FOV: 45 degrees:
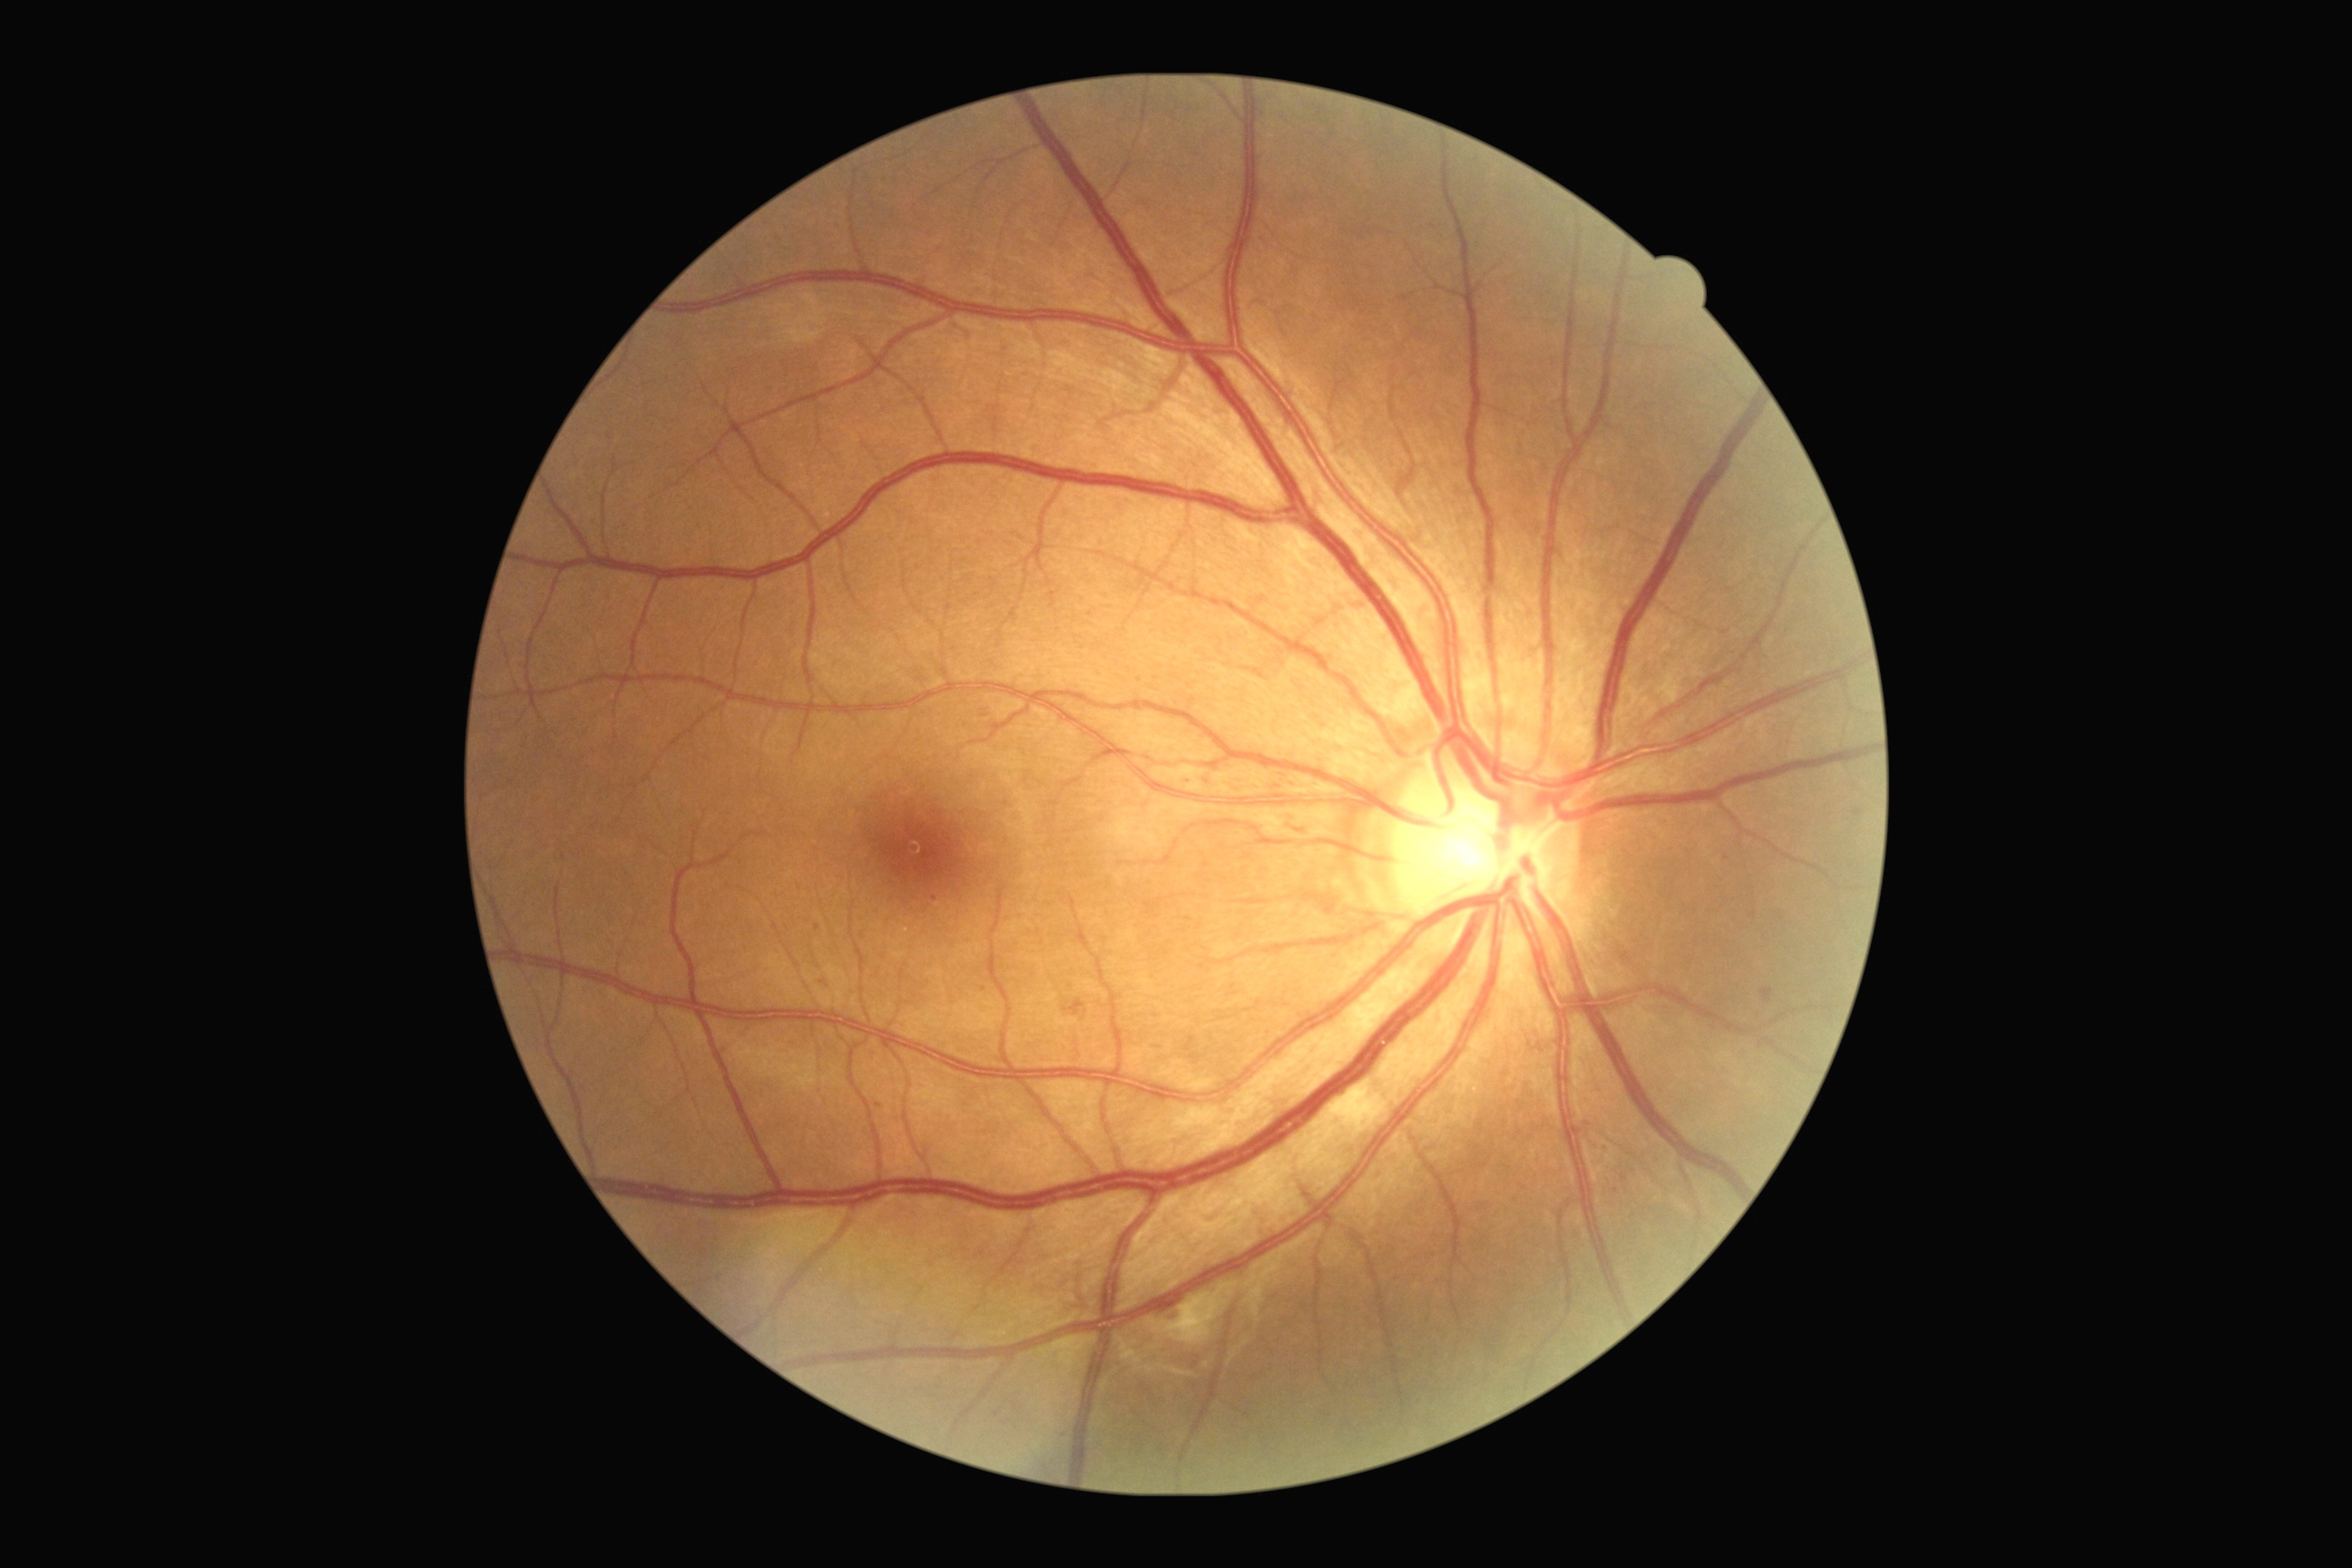

Diabetic retinopathy severity is grade 2 — more than just microaneurysms but less than severe NPDR.